Nonmydriatic:
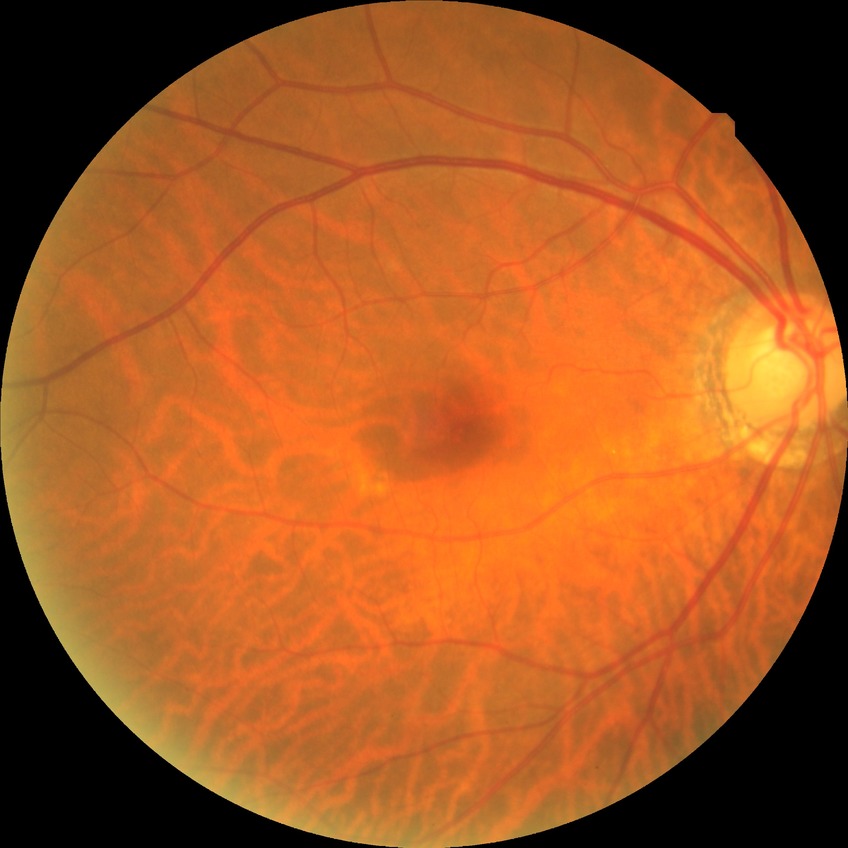
Davis grading is no diabetic retinopathy.